Captured with the Natus RetCam Envision (130° field of view); image size 1440x1080; infant wide-field retinal image.
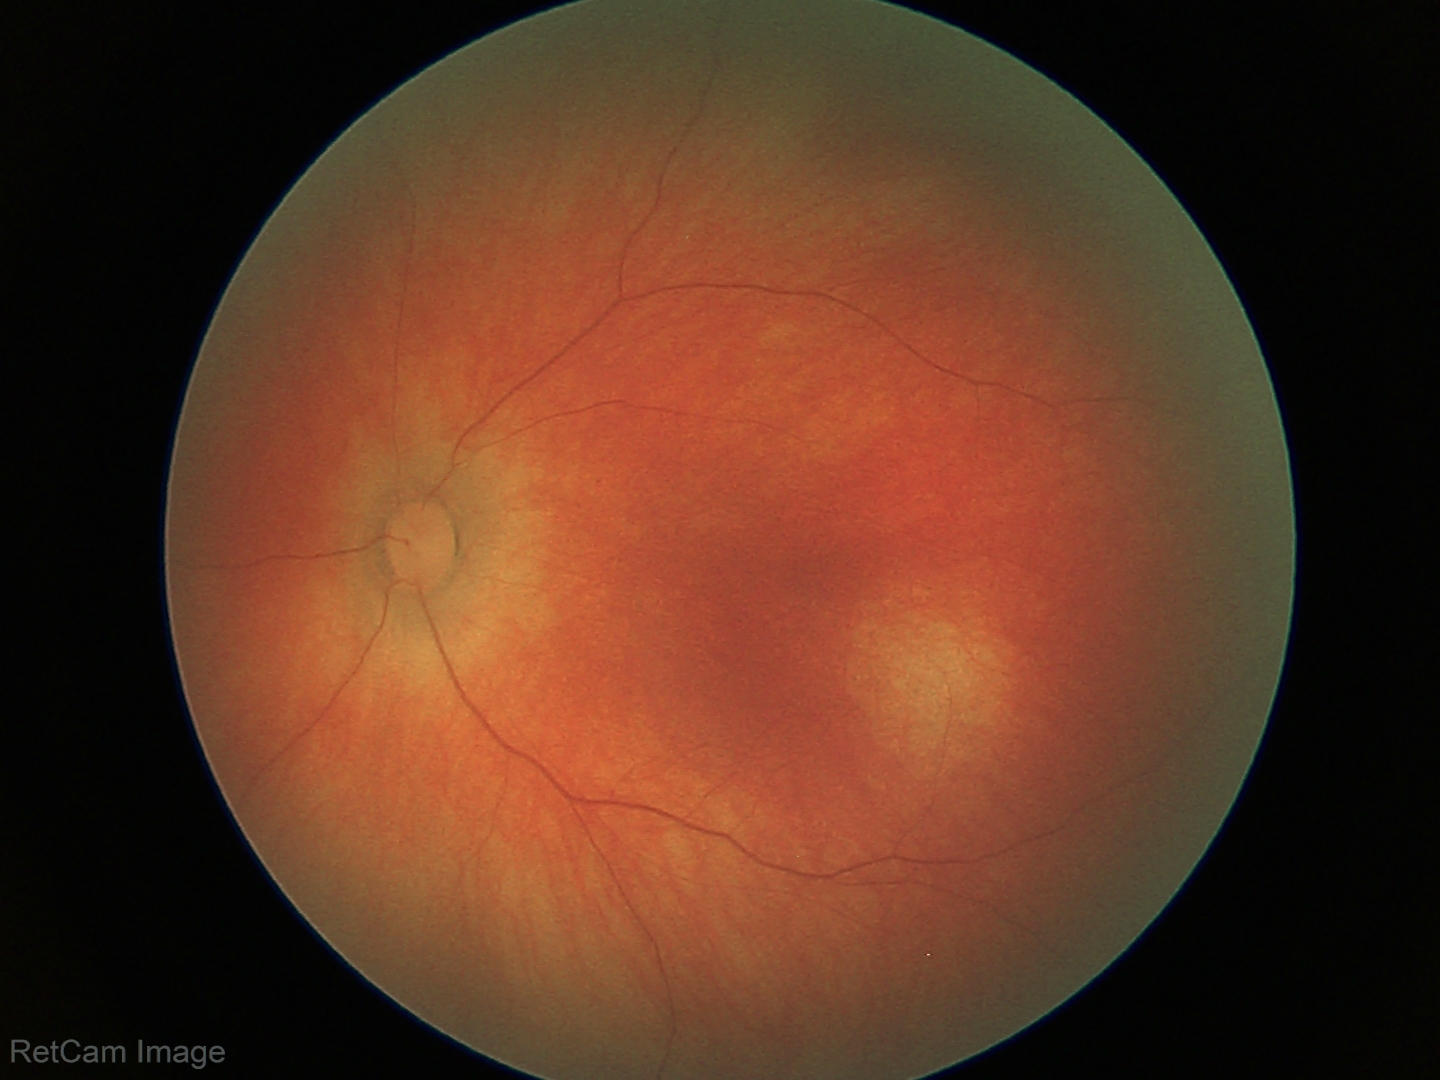
Screening examination diagnosed as physiological.